Posterior pole photograph, no pharmacologic dilation:
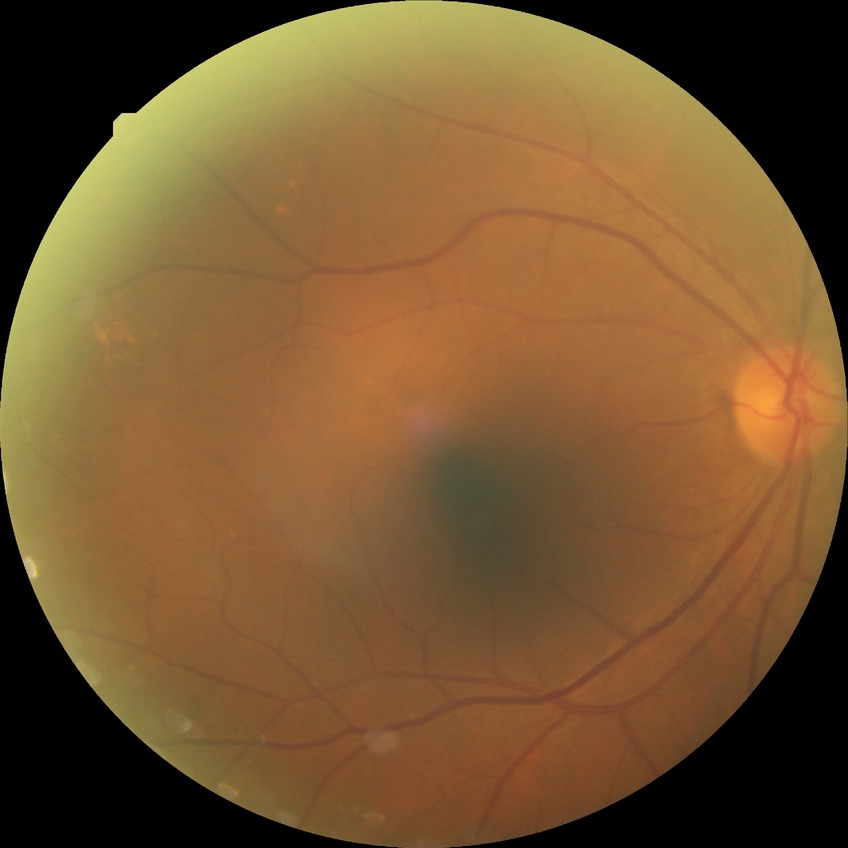
Retinopathy stage is no diabetic retinopathy.